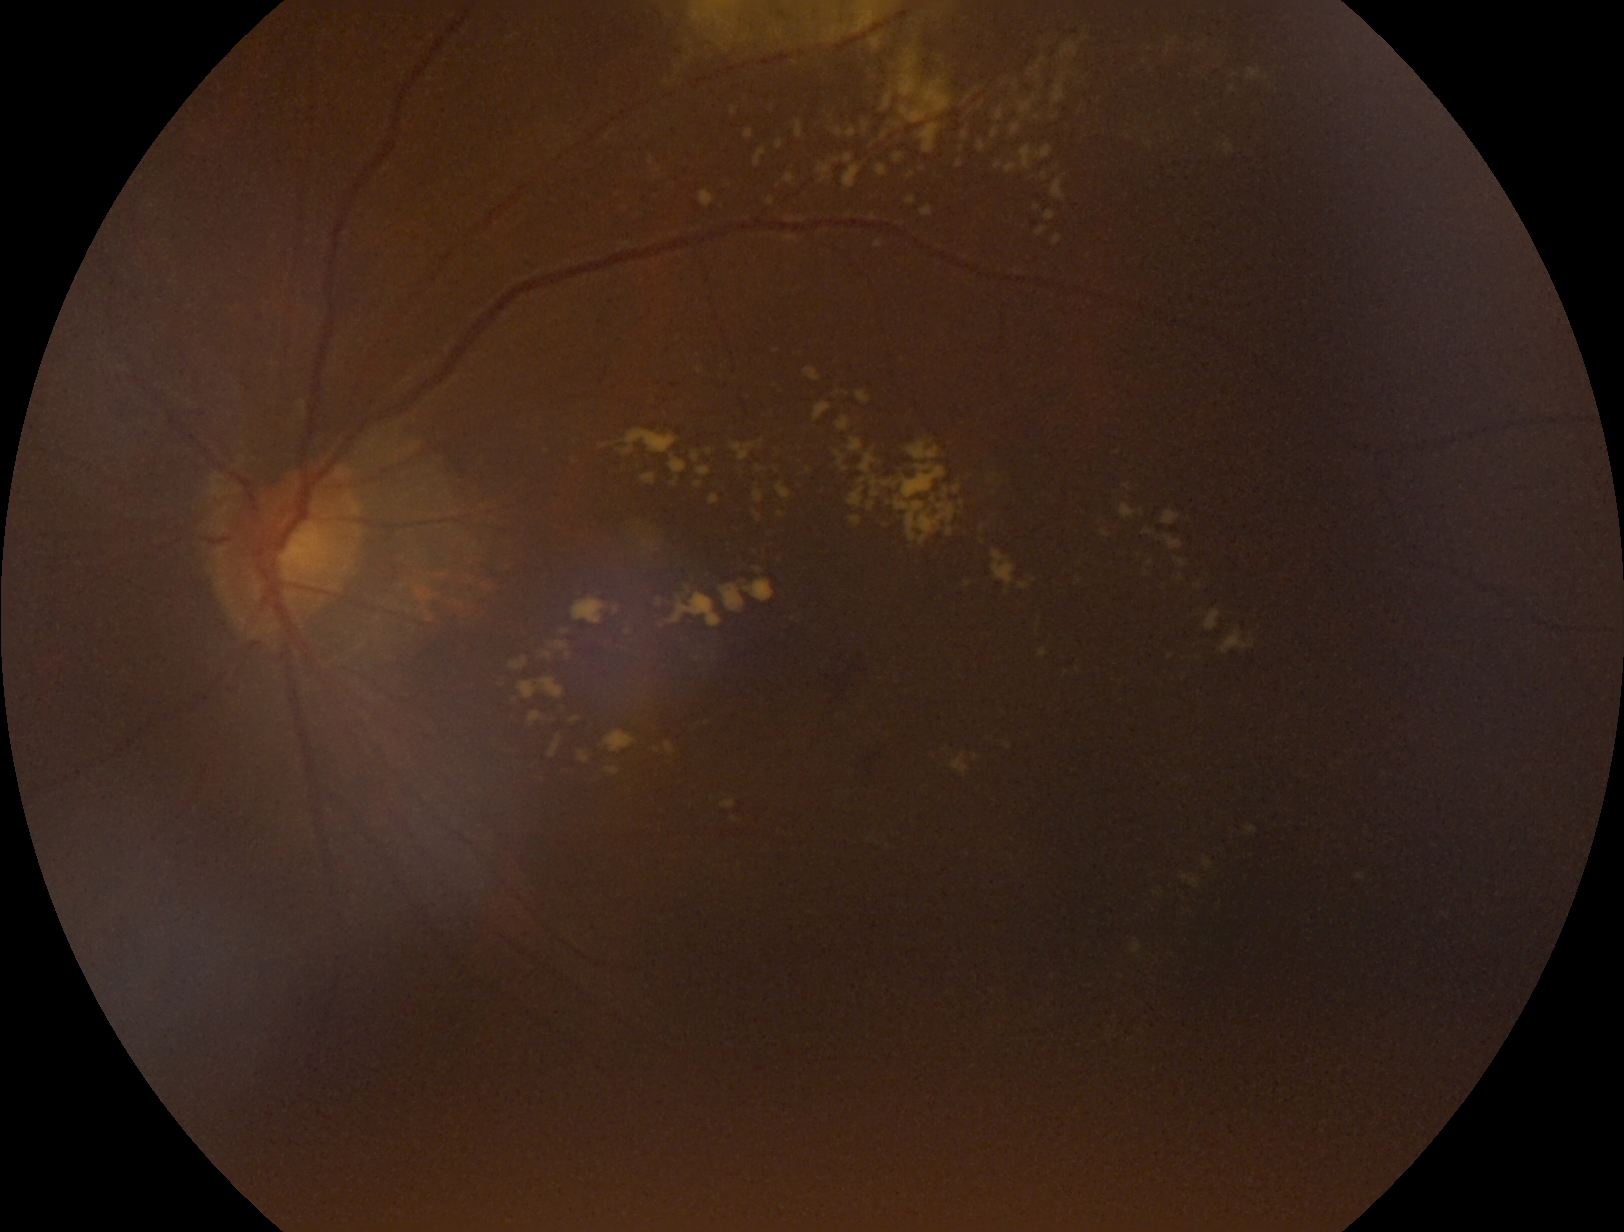
Diabetic retinopathy (DR) is 2/4.